Tabletop color fundus camera image: 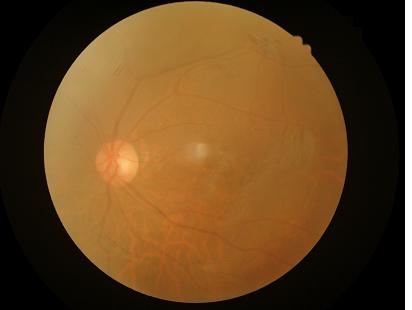

Image quality: overall: inadequate for clinical interpretation; illumination: no over- or under-exposure; focus: out of focus, structures indistinct; contrast: narrow intensity range, structures hard to distinguish.